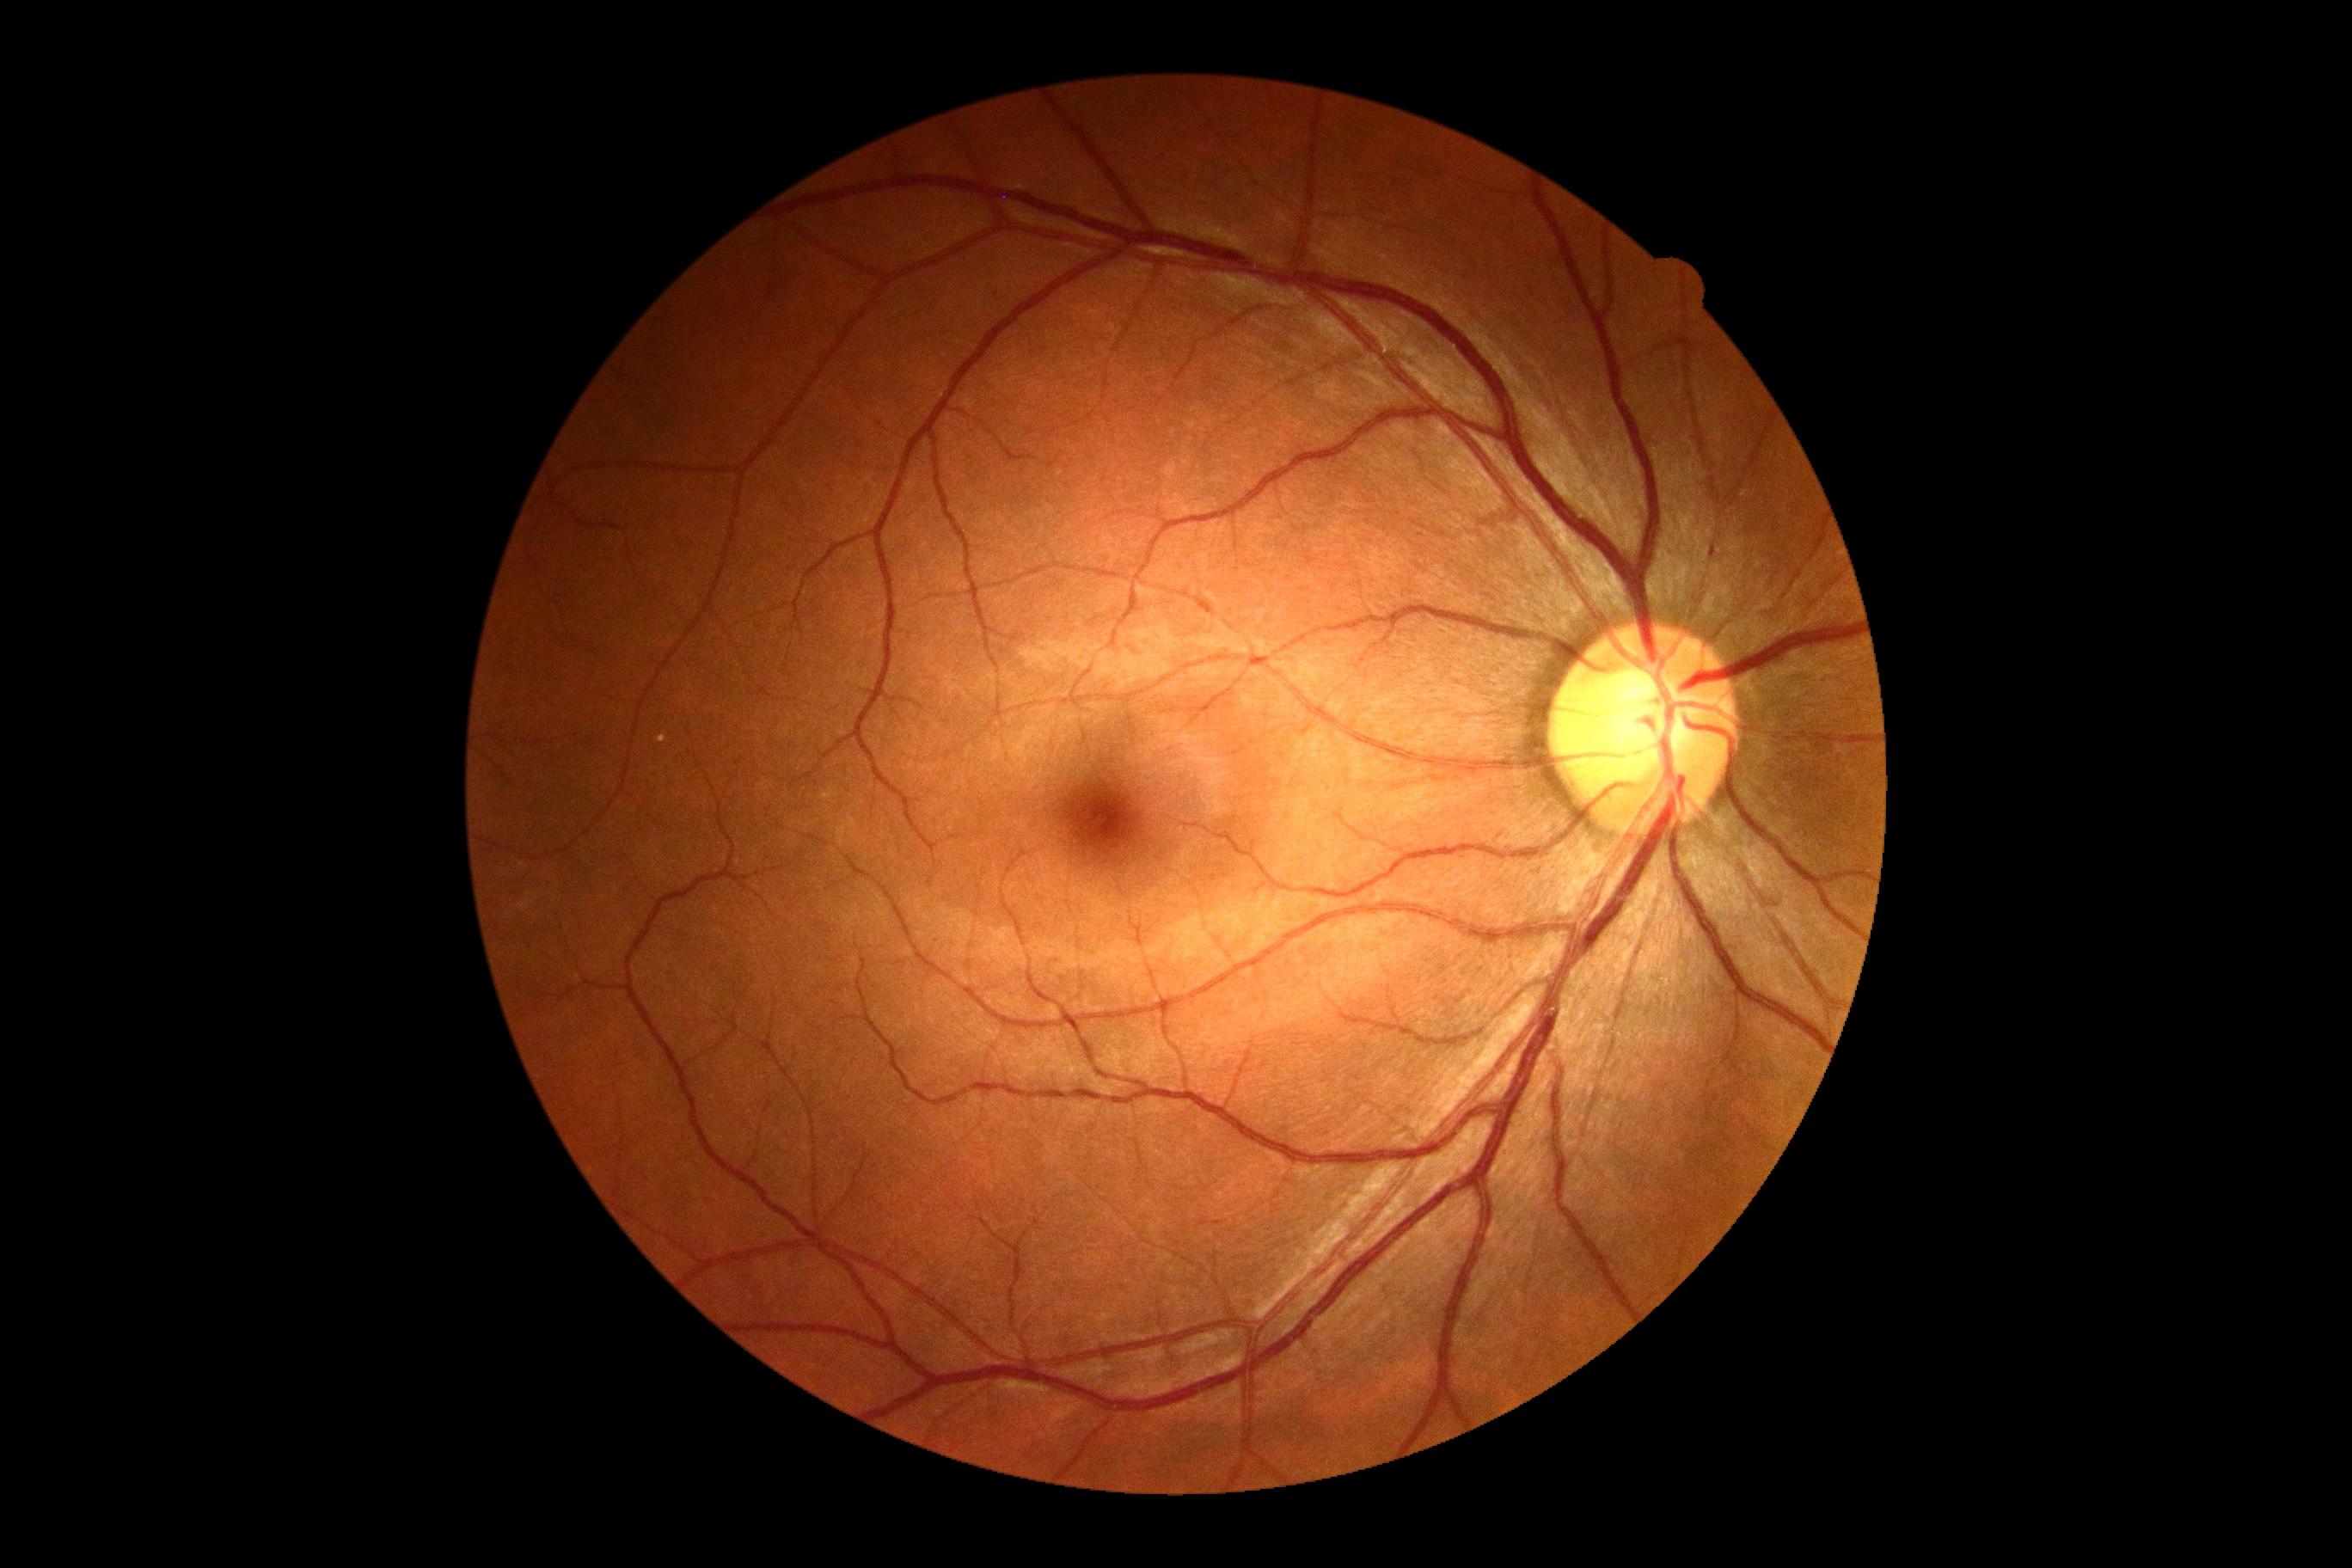 {
  "dr_impression": "negative for DR",
  "dr_grade": "grade 0 (no apparent retinopathy)"
}